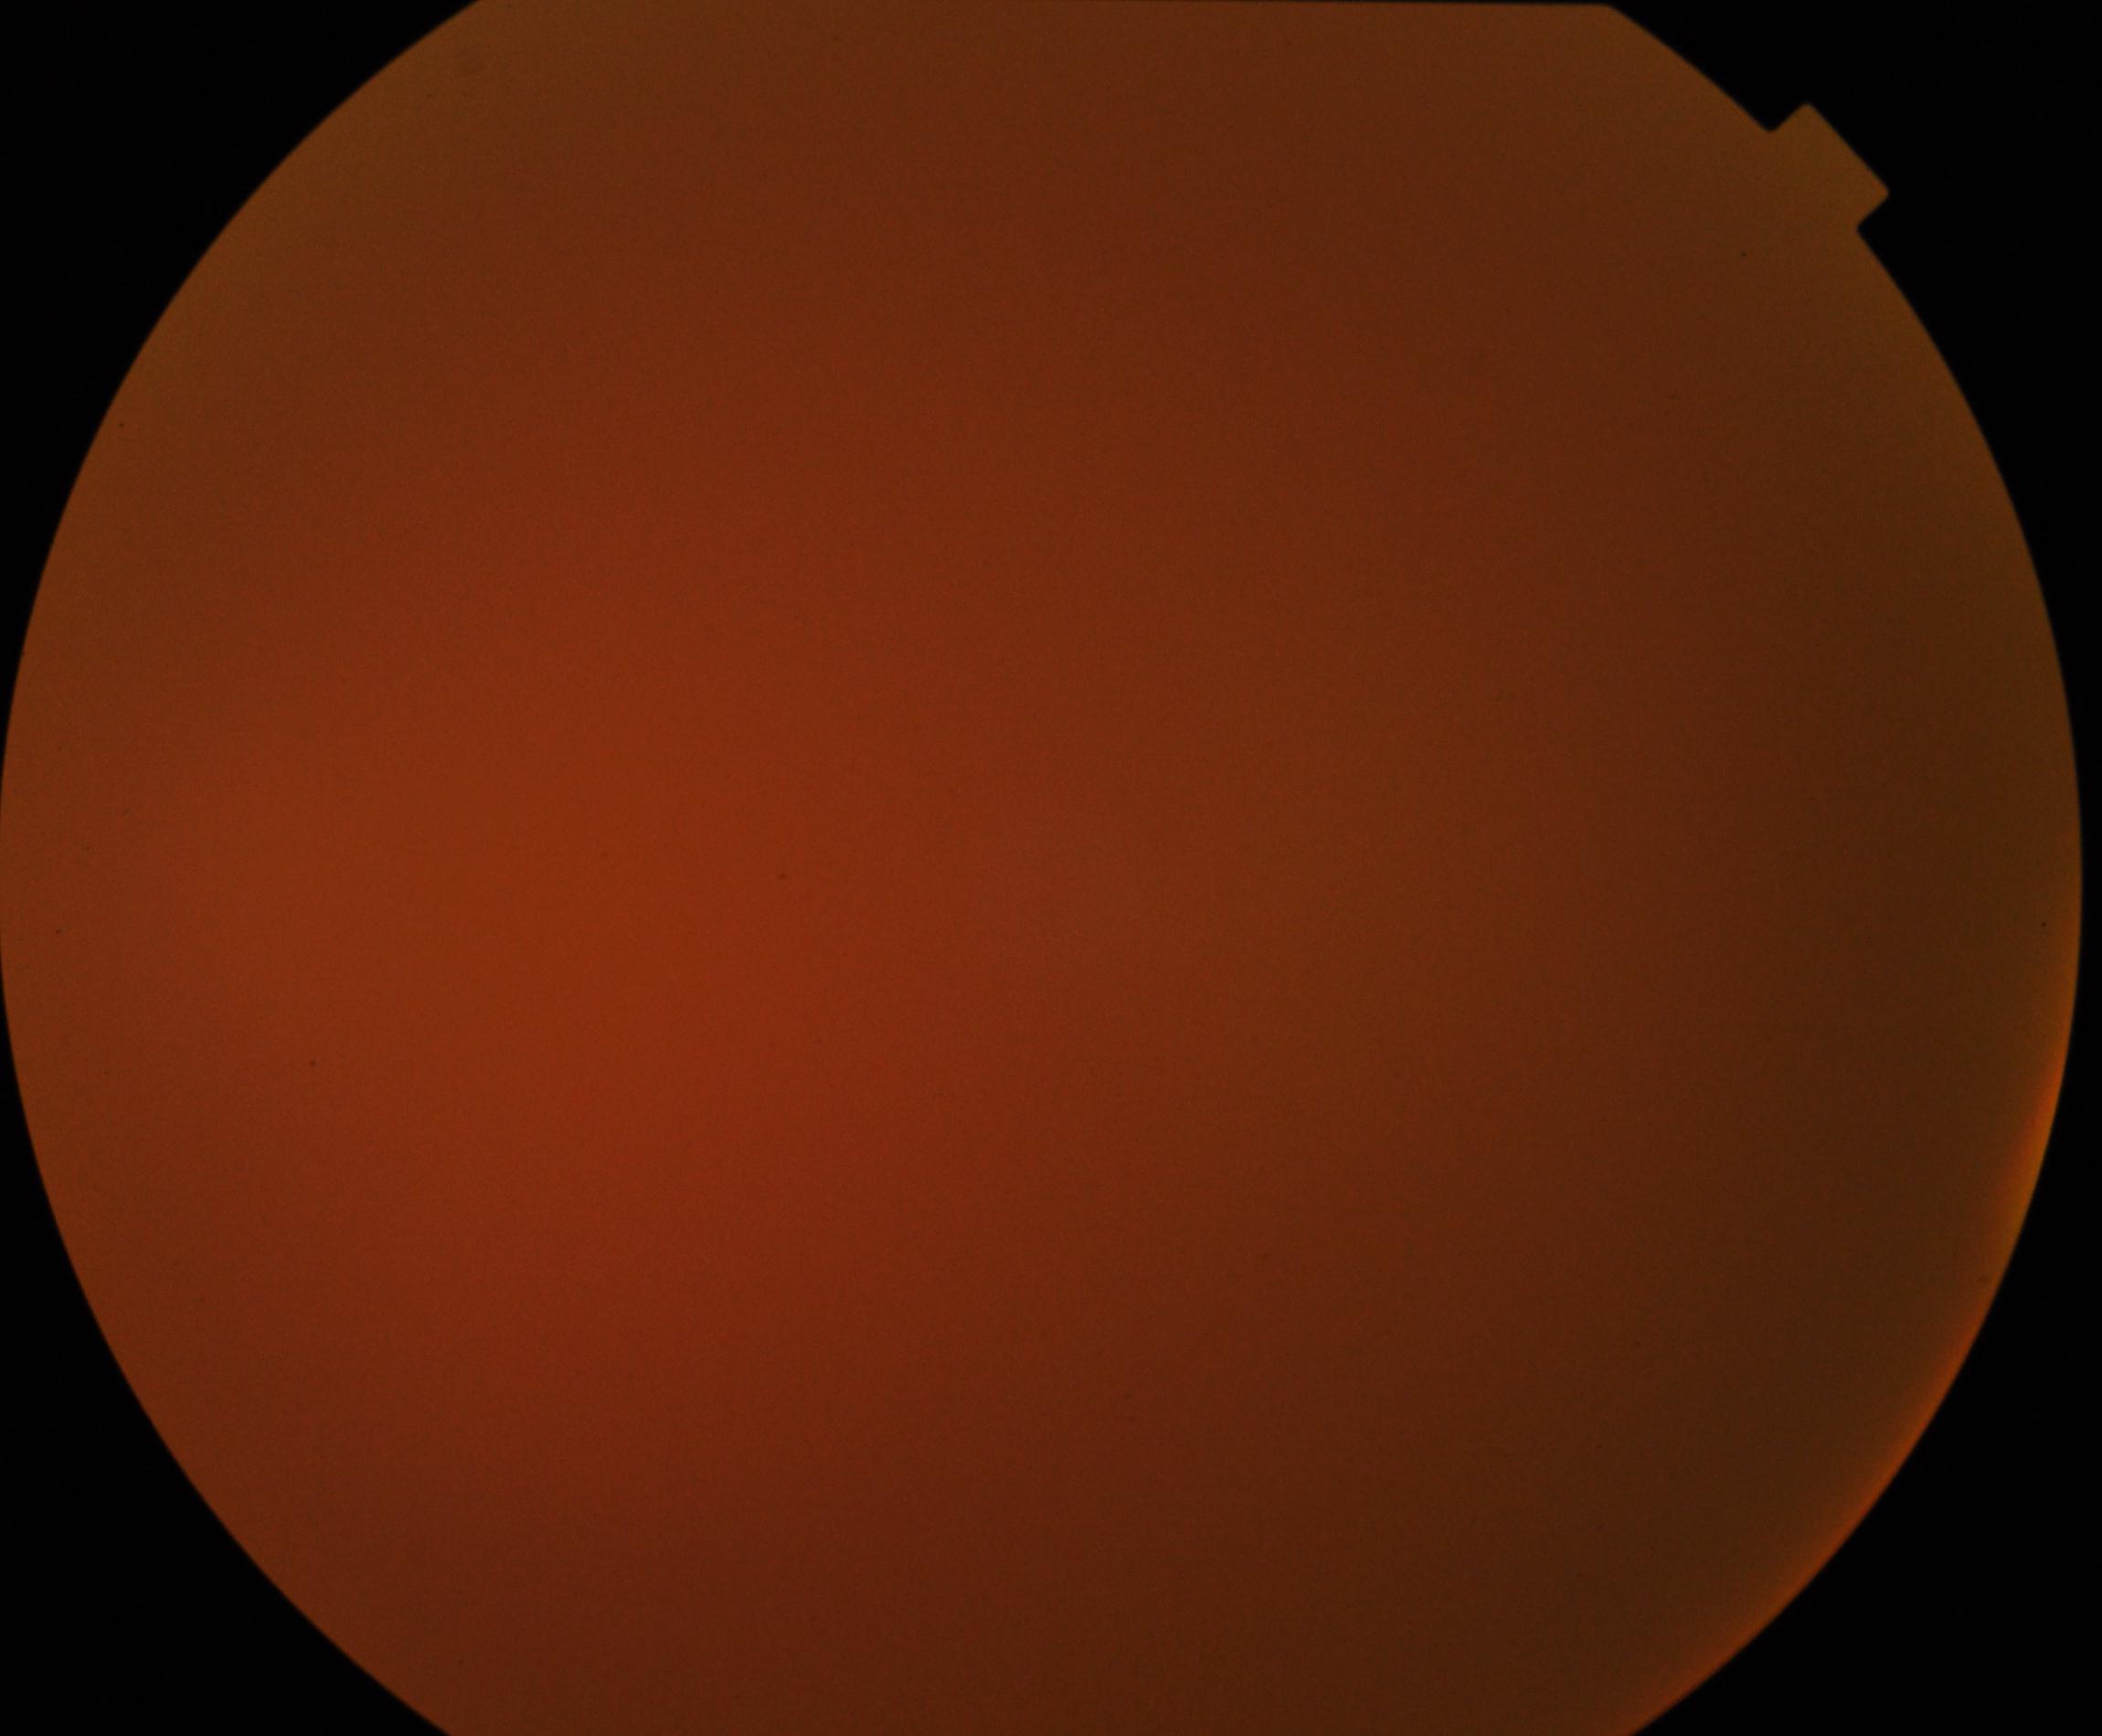 Quality: significantly degraded. Proliferative diabetic retinopathy: not identified.